Retinal fundus photograph
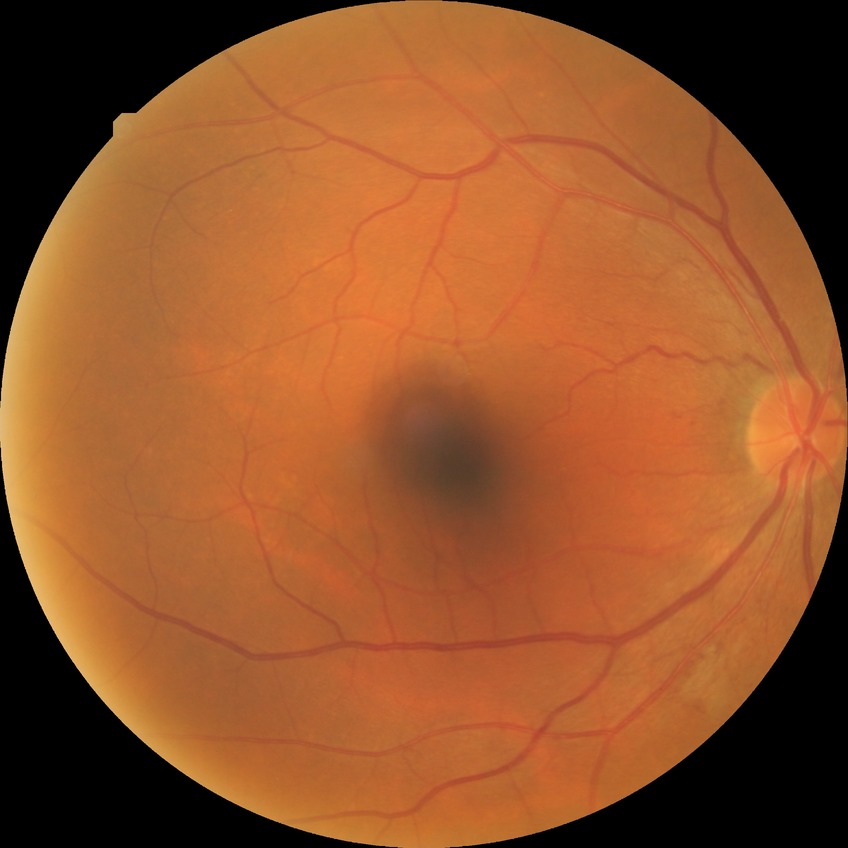 diabetic retinopathy (DR): SDR (simple diabetic retinopathy); DR class: non-proliferative diabetic retinopathy.